FOV: 45 degrees — 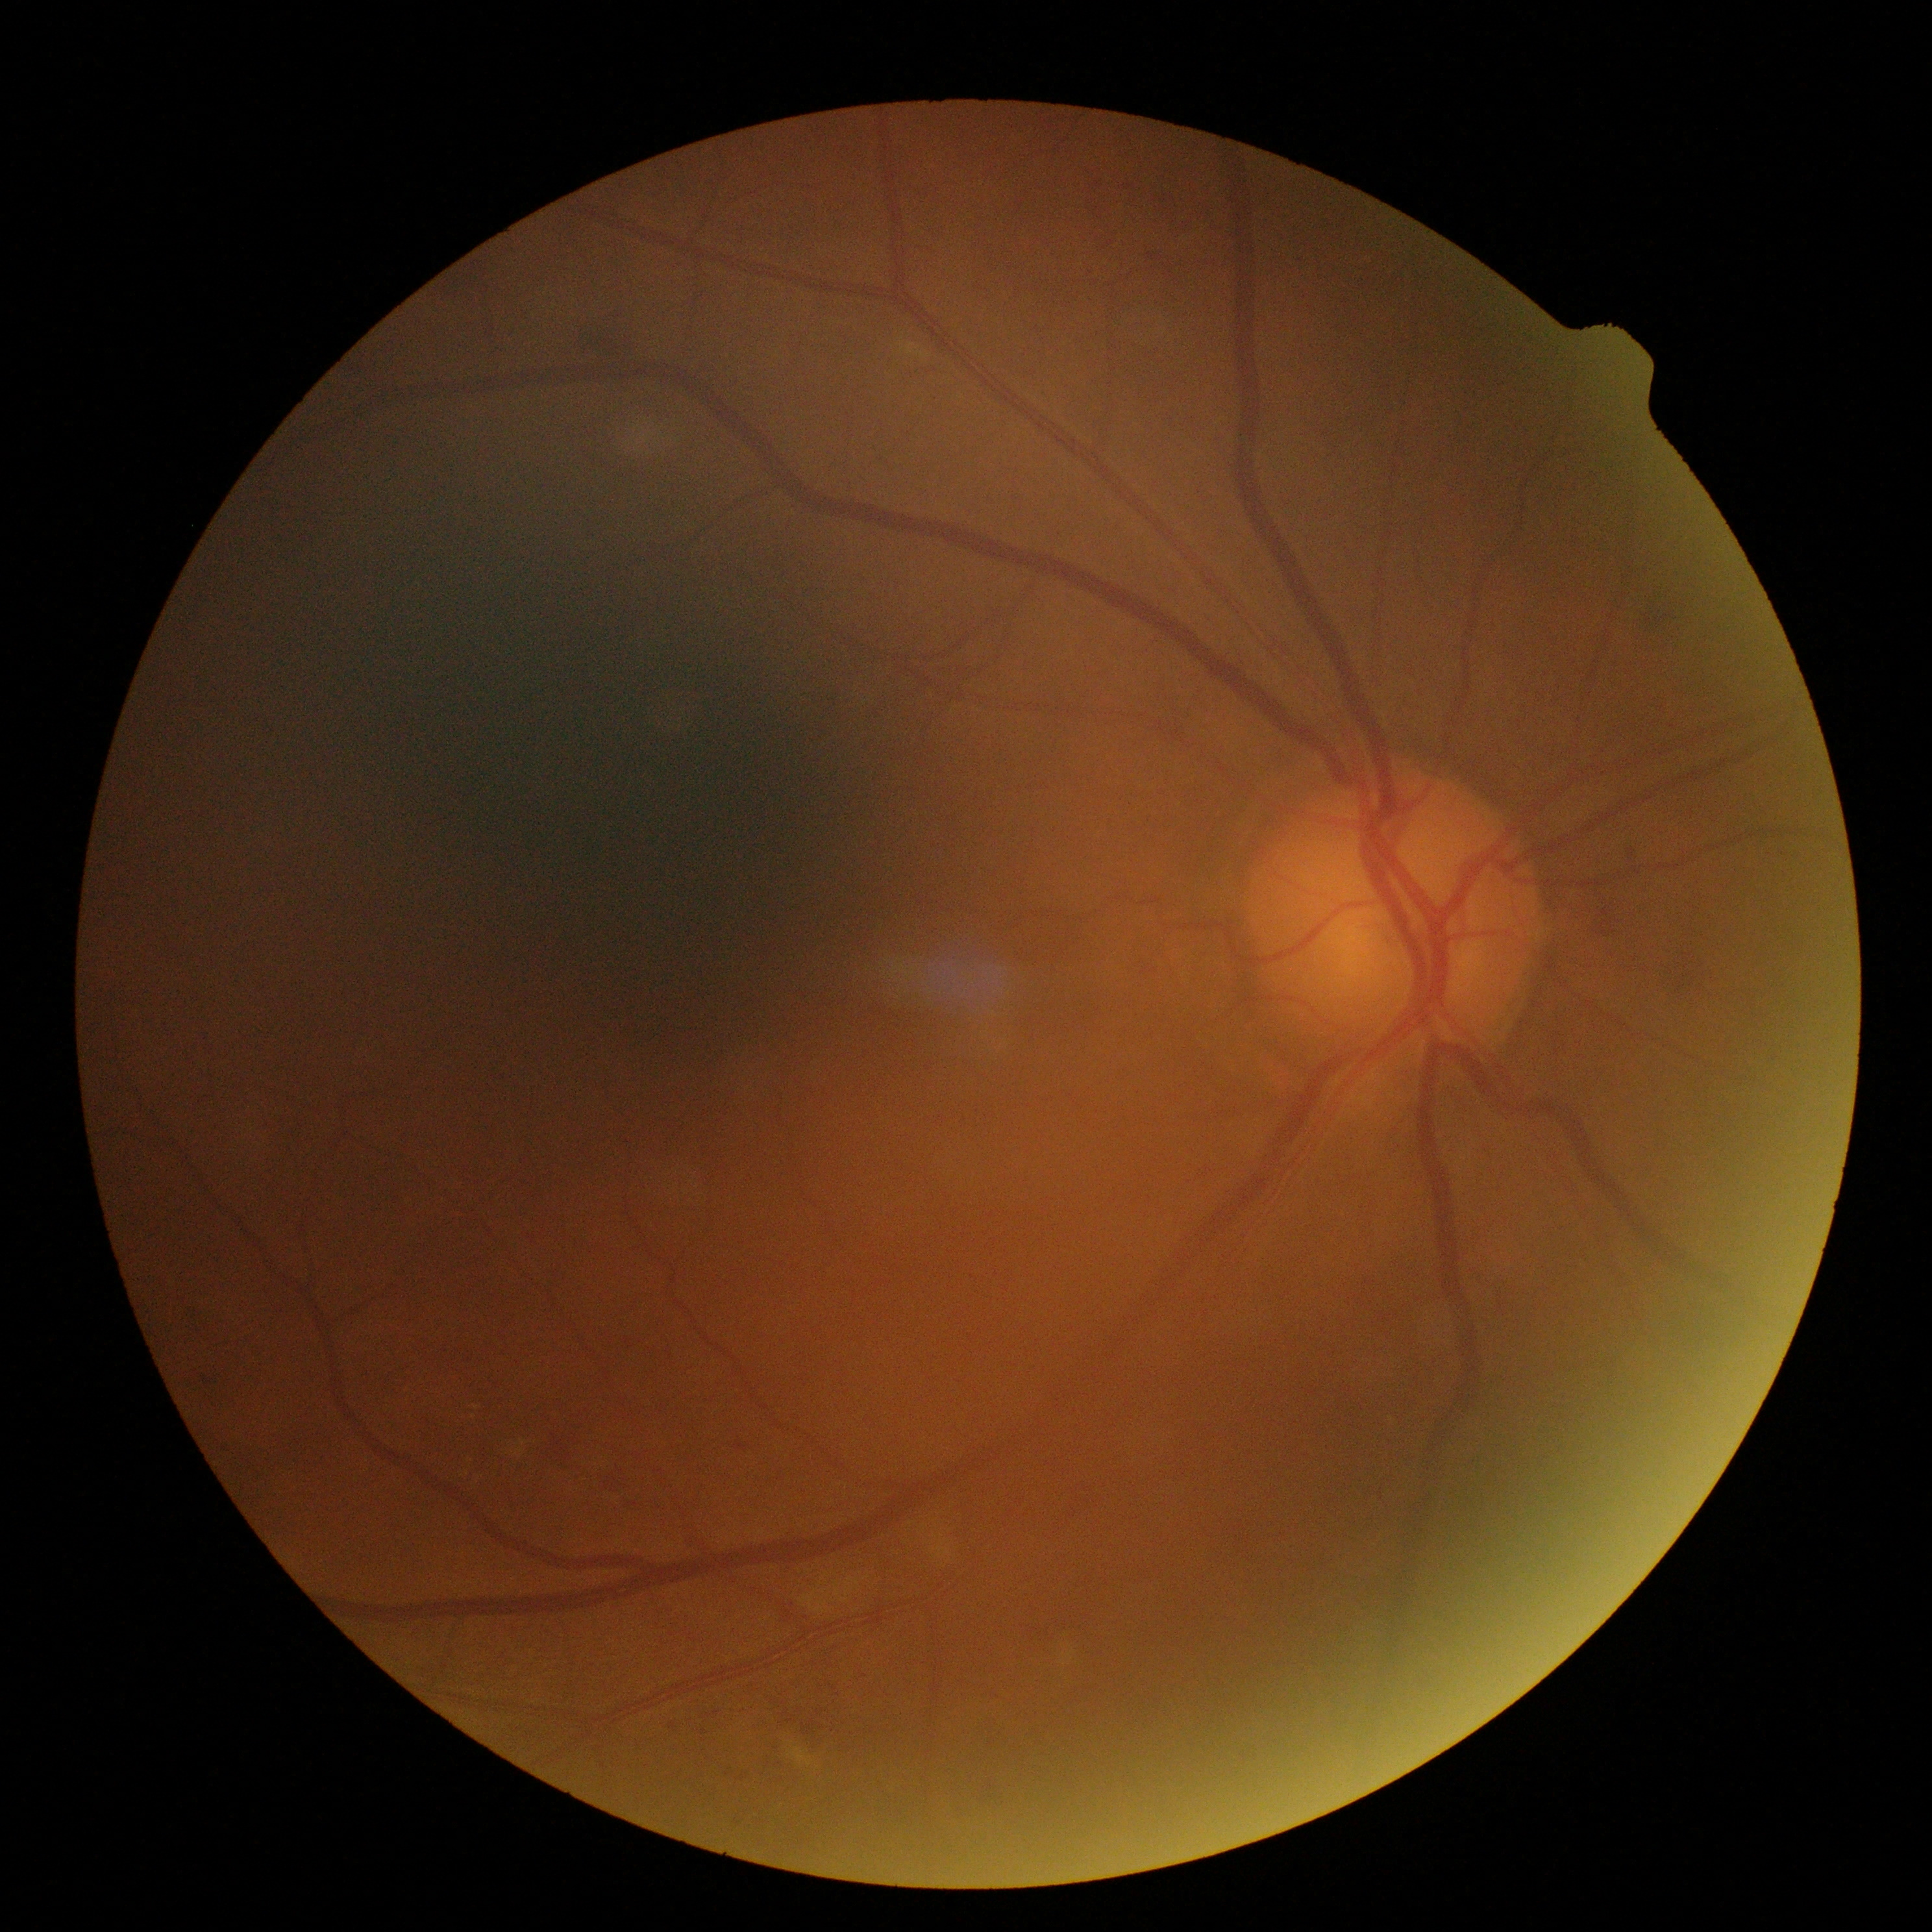

DR grade: moderate non-proliferative diabetic retinopathy (2).